Color fundus image. 2212x1659:
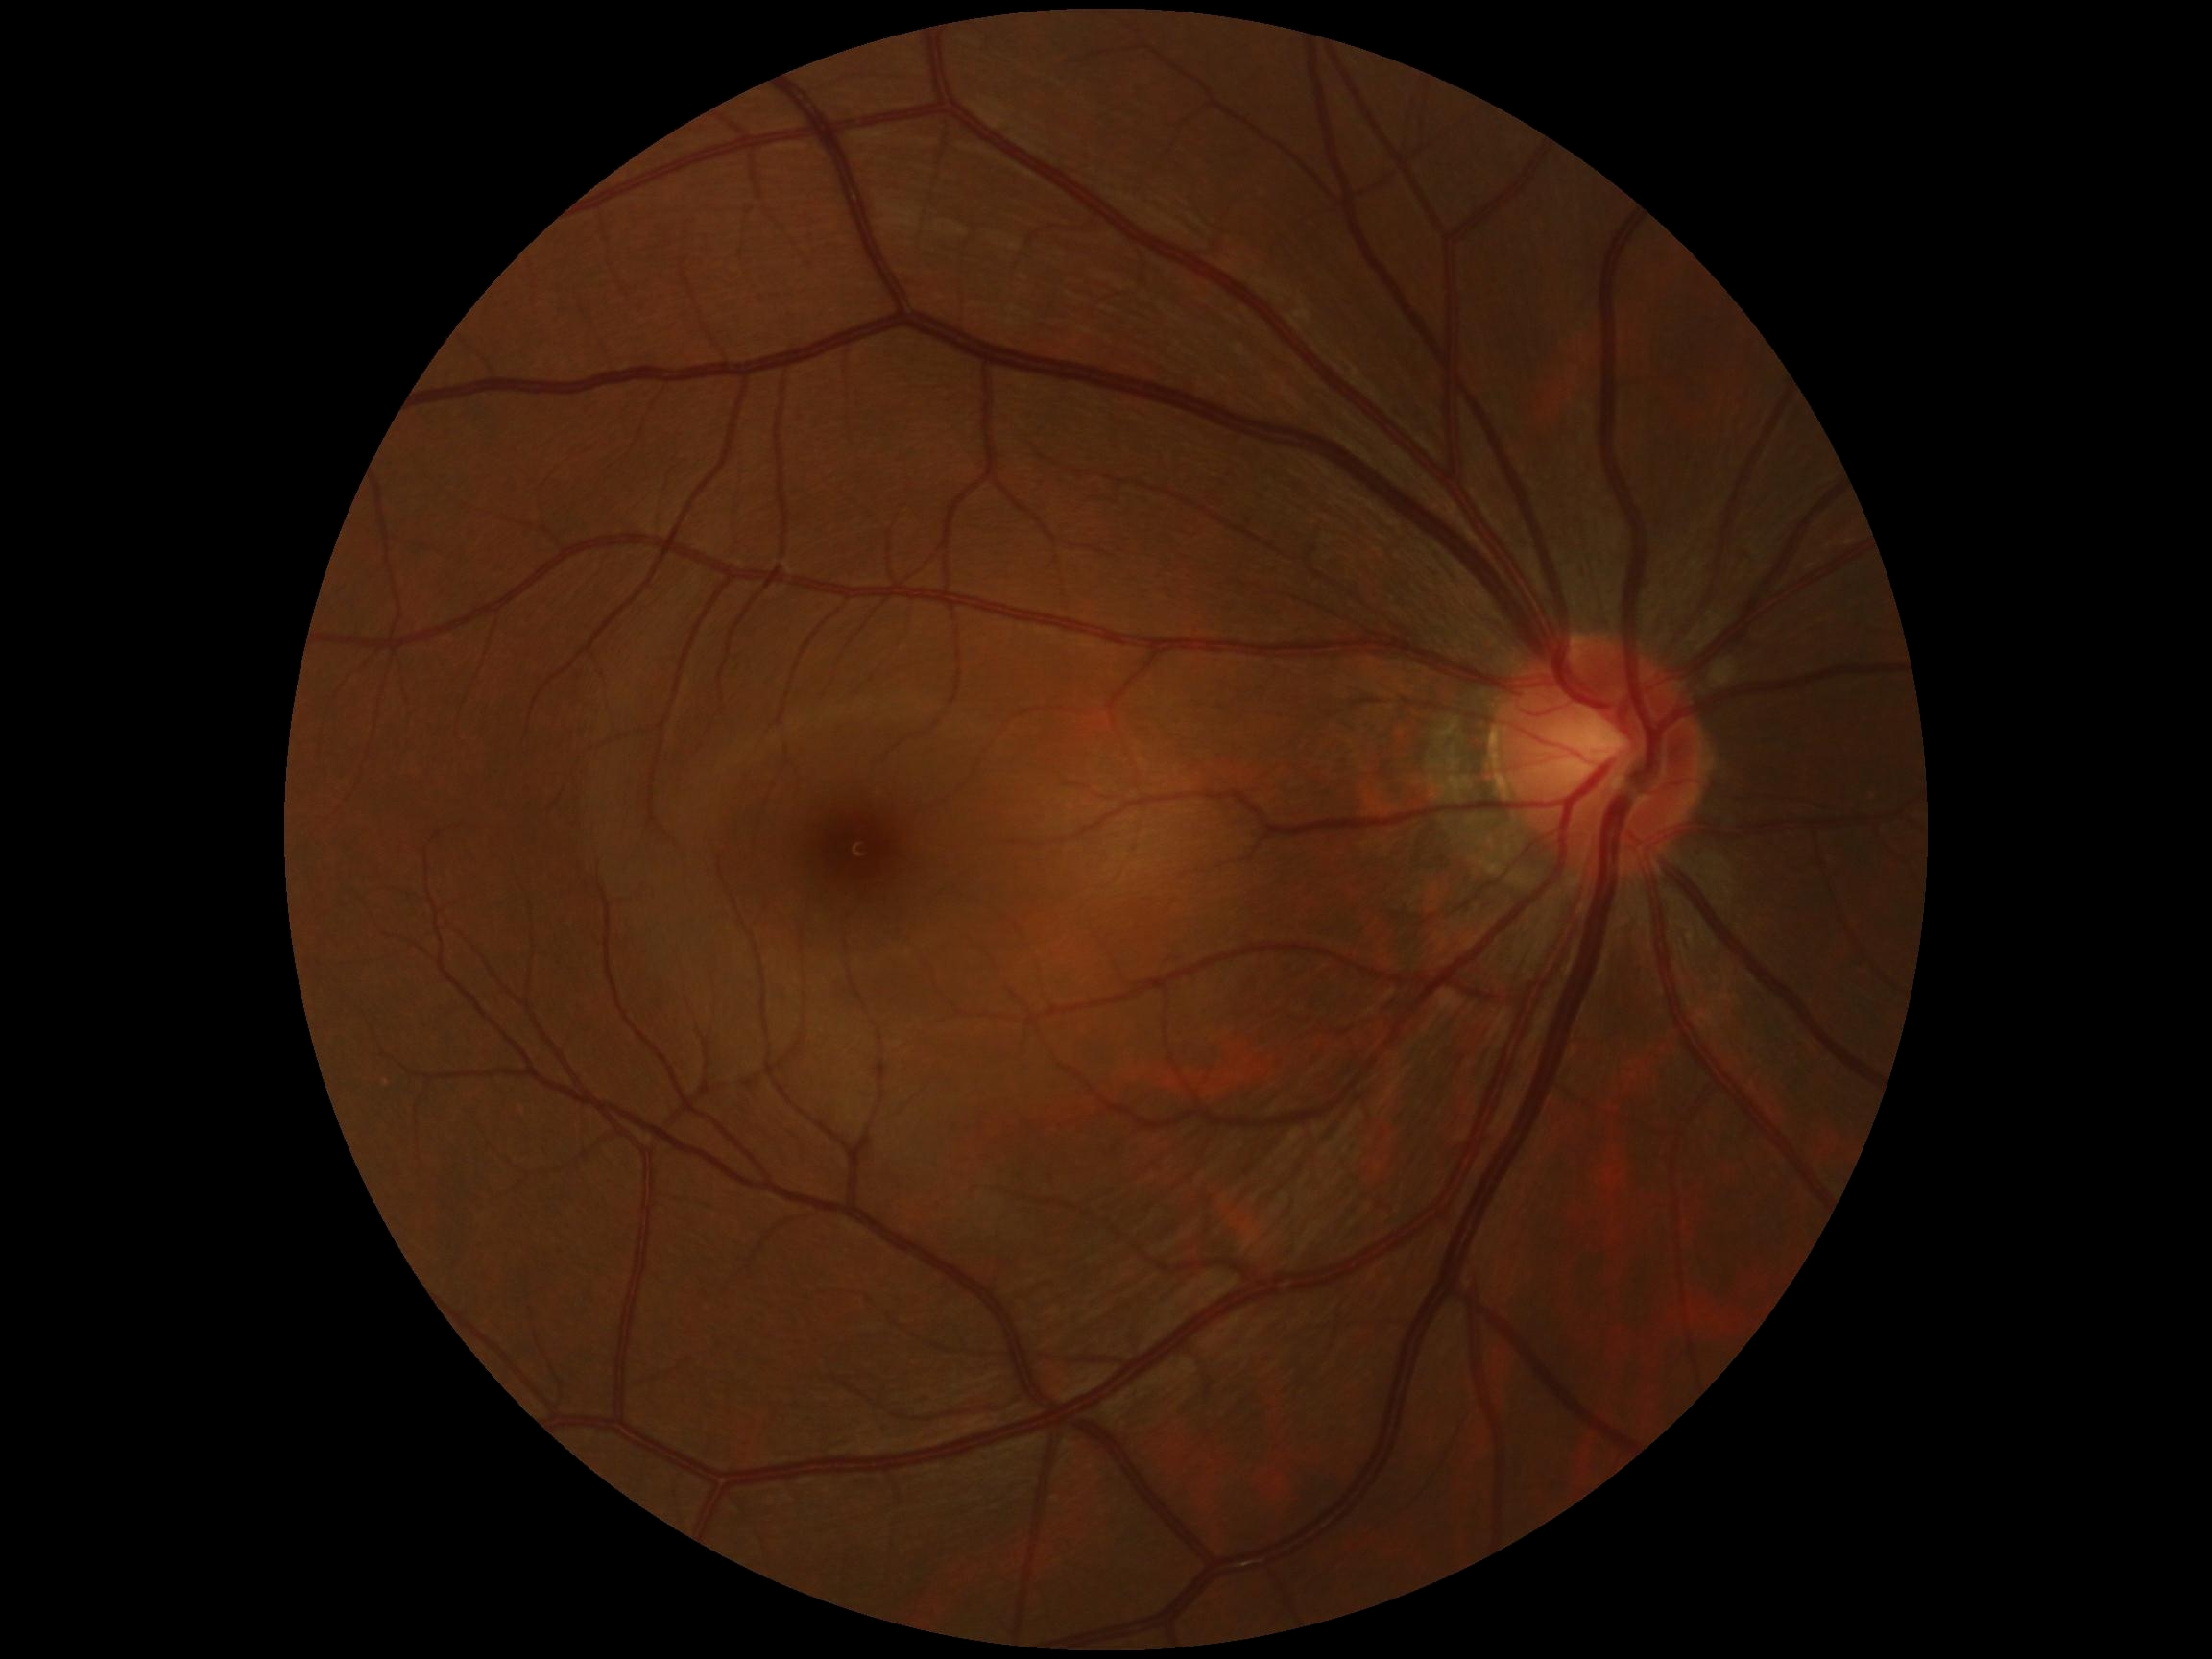

DR severity=no apparent retinopathy (grade 0).